640 x 480 pixels. Pediatric retinal photograph (wide-field).
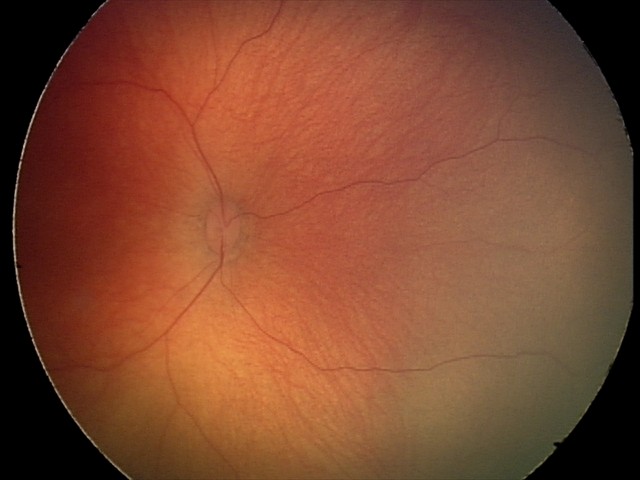
Screening diagnosis: retinal hemorrhages.